45° FOV:
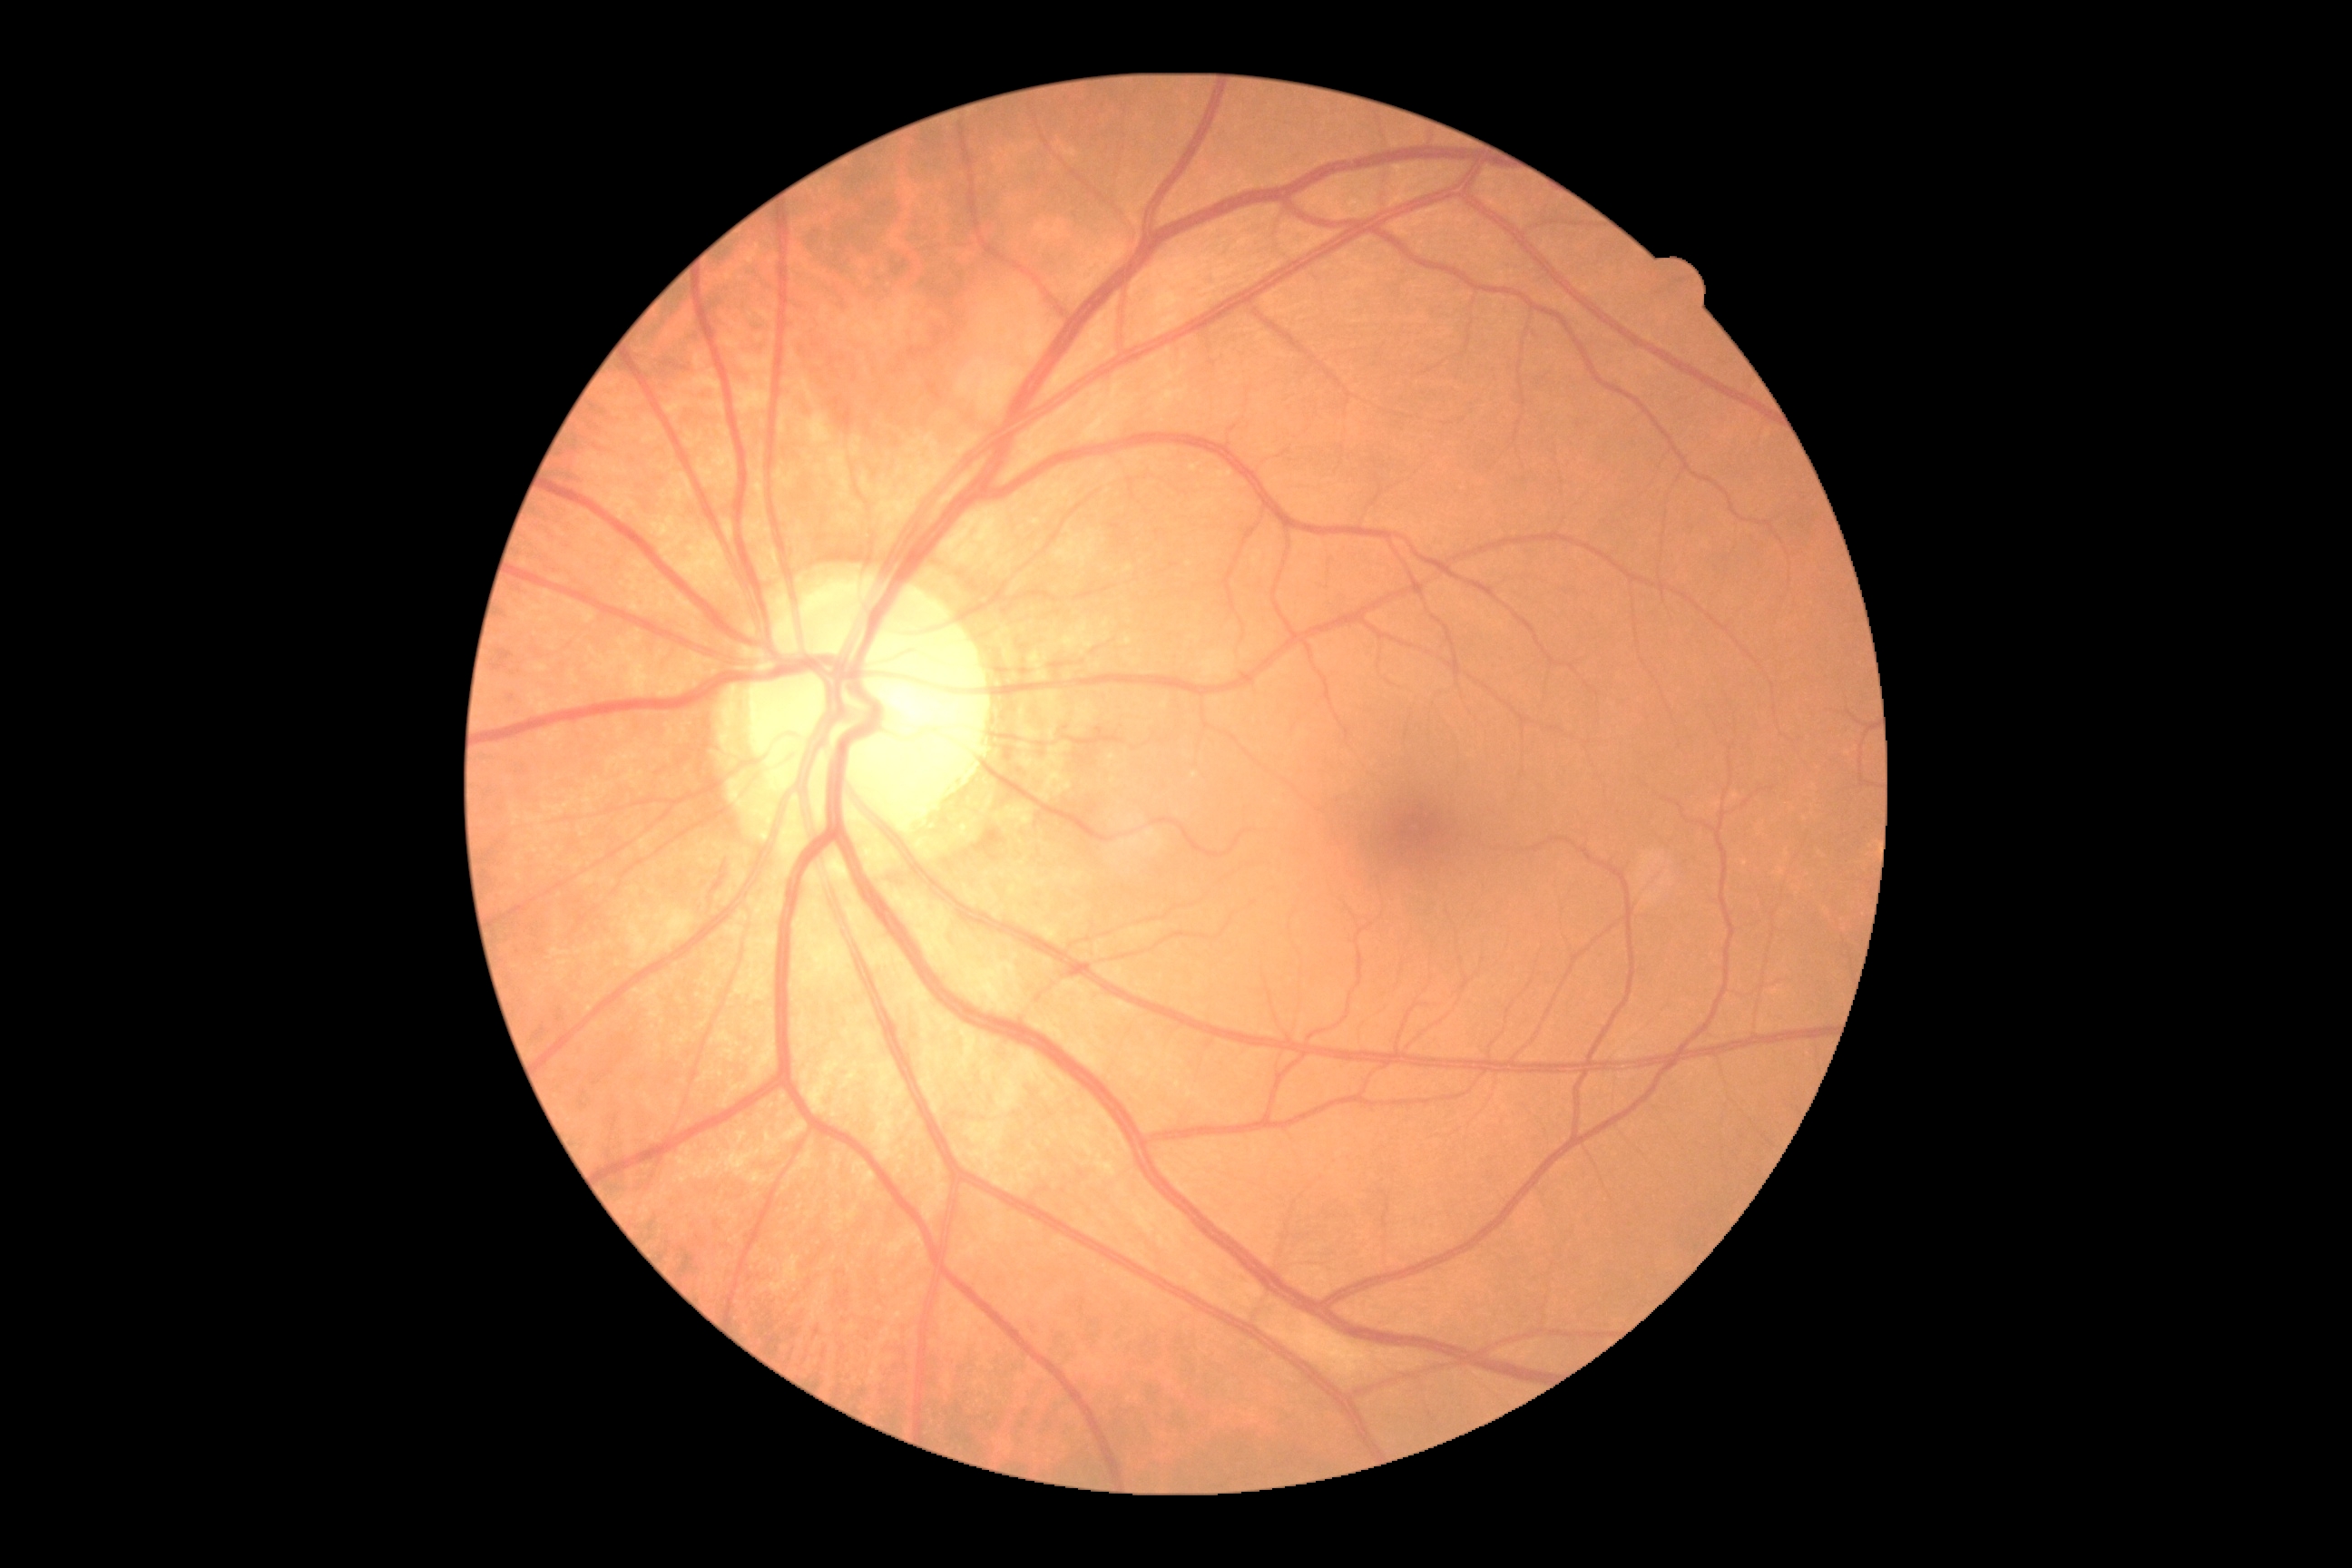
DR class=non-proliferative diabetic retinopathy; diabetic retinopathy=moderate non-proliferative diabetic retinopathy (grade 2).